Captured with the Phoenix ICON (100° field of view); Phoenix ICON wide-field infant fundus image
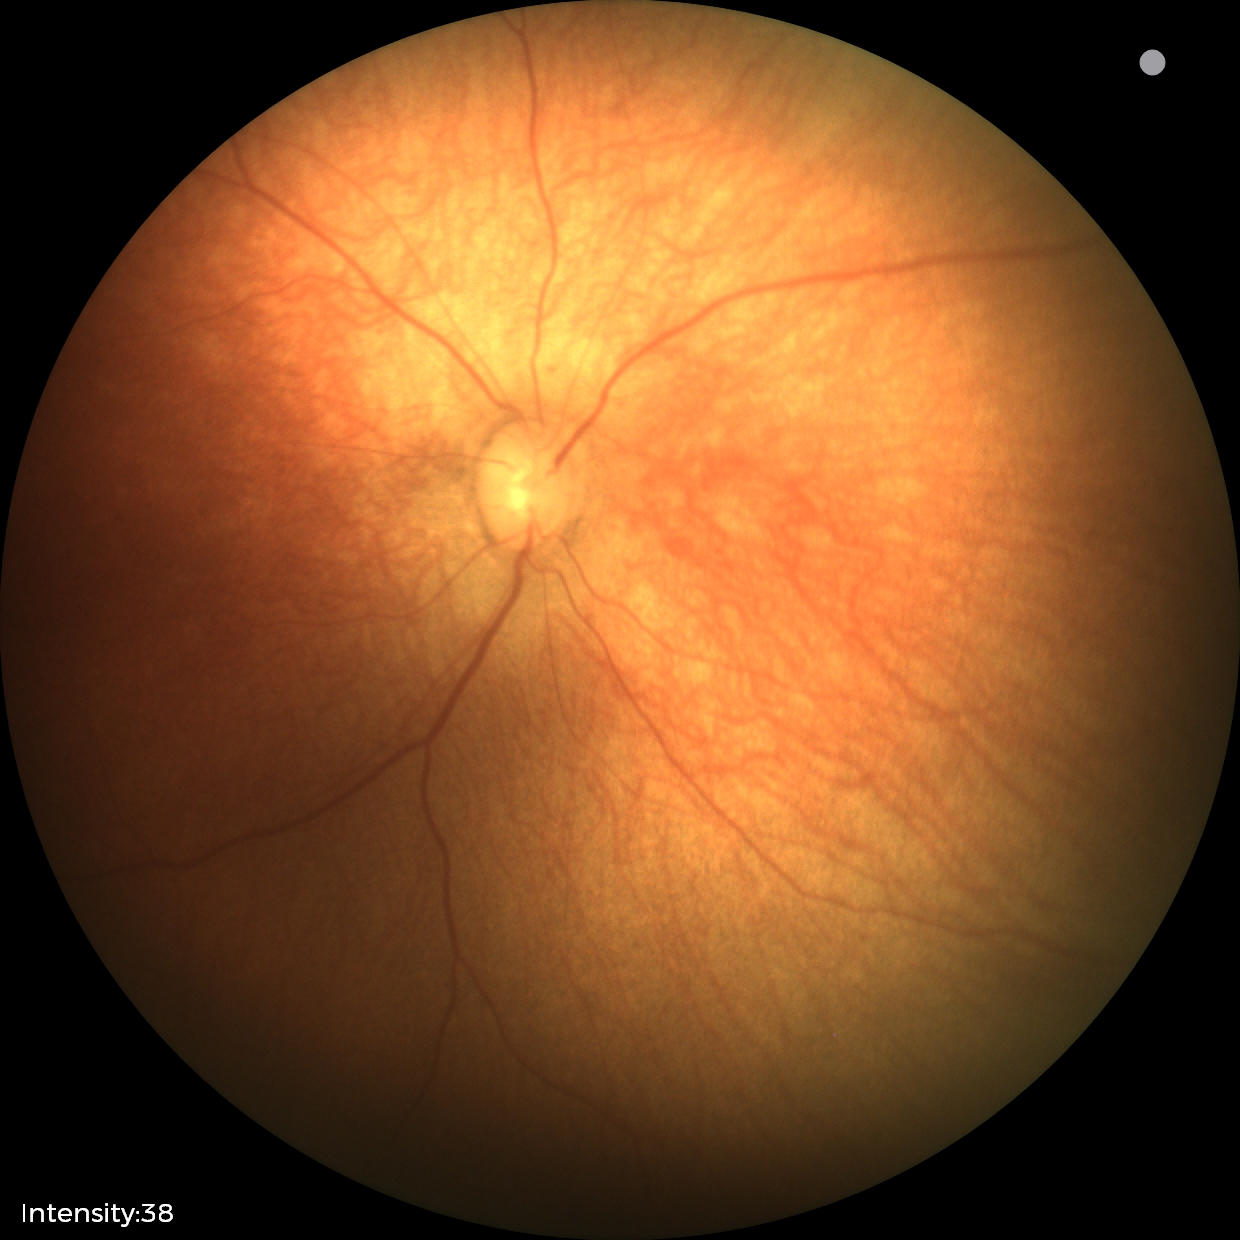 Examination with physiological retinal findings.